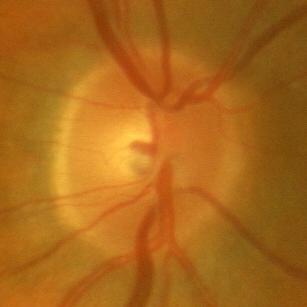
ONH-centered fundus image showing no glaucoma.